Phoenix ICON wide-field infant fundus image — 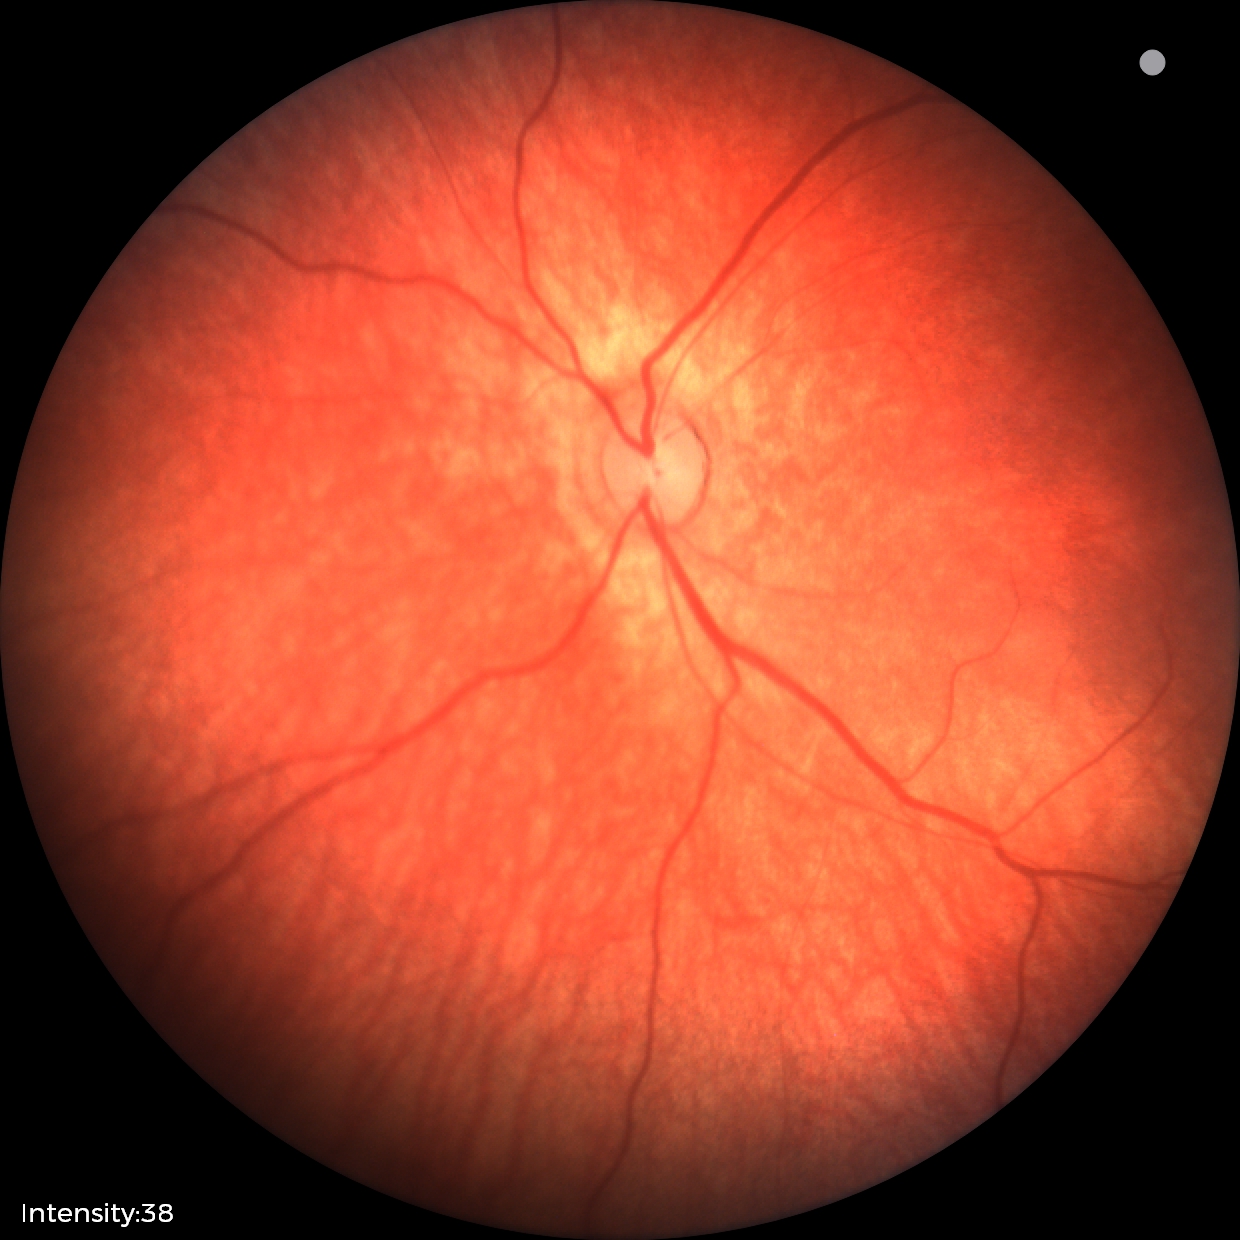
Diagnosis = no abnormalities.